Captured with pupil dilation · color fundus photograph centered on the optic disc · cropped from a 35-degree field of view:
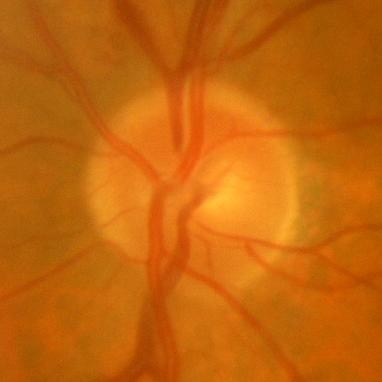
Consistent with no evidence of glaucoma.